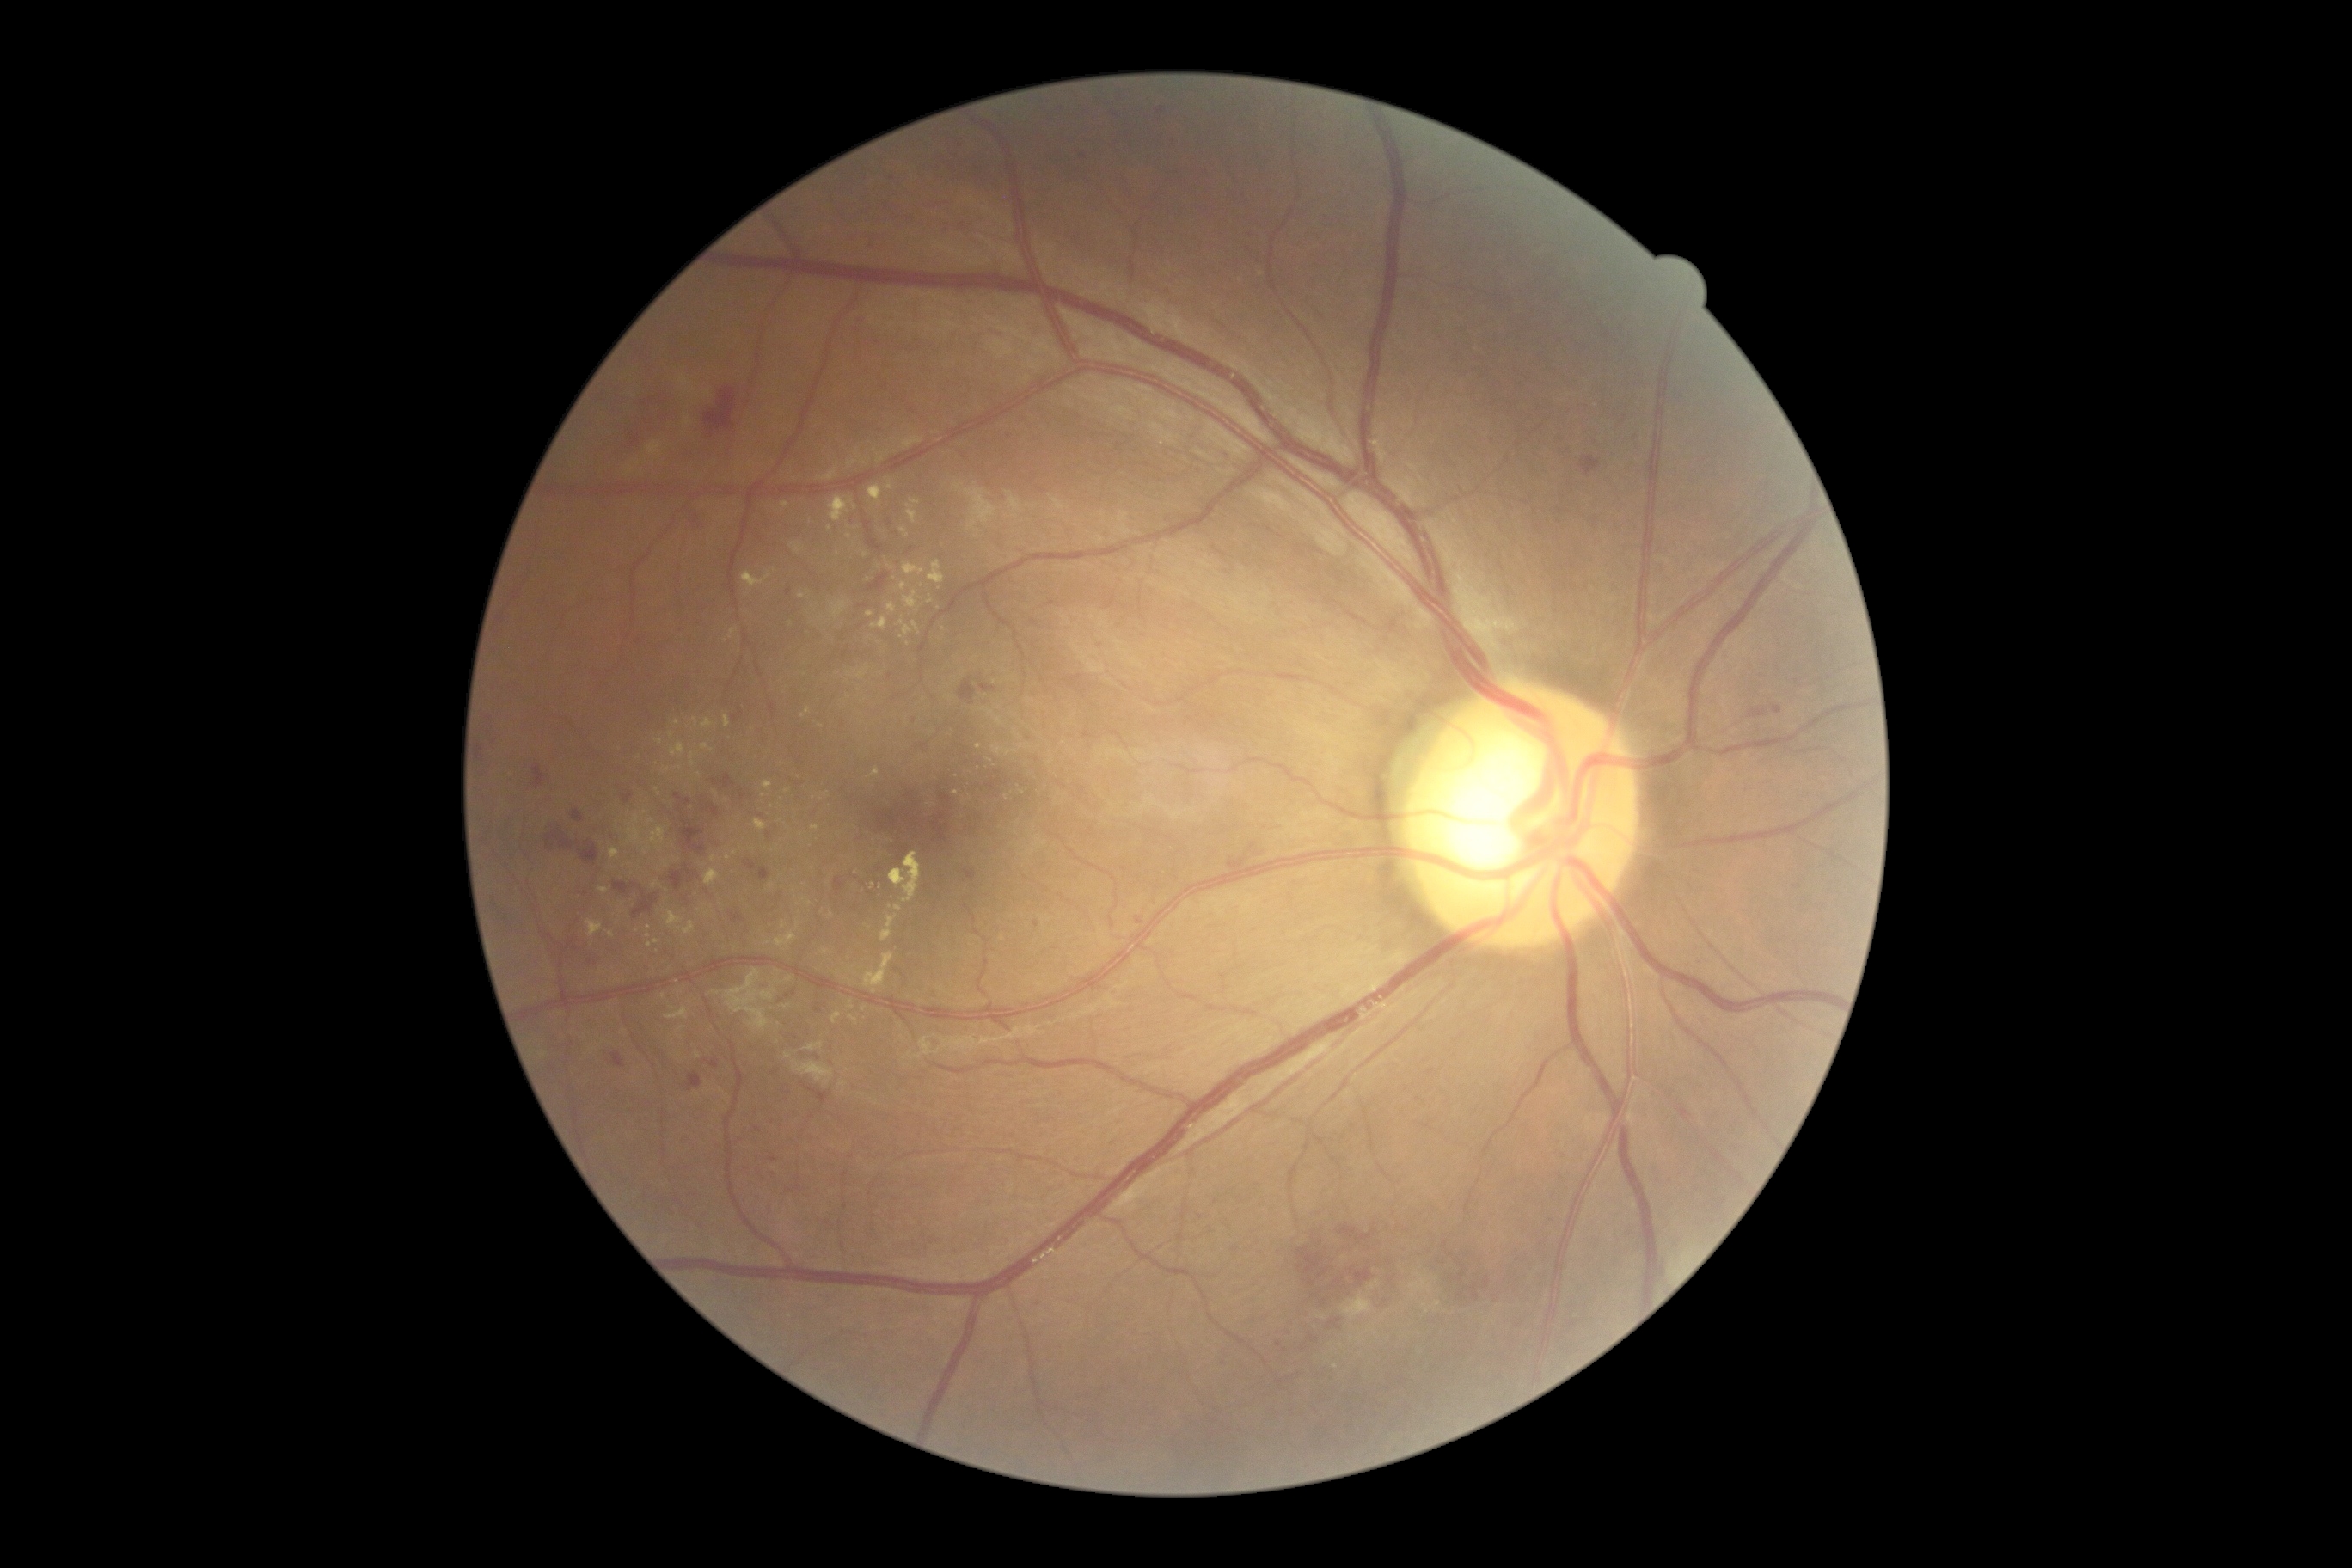

<lesions partial="true">
  <dr_grade>2</dr_grade>
  <ex partial="true"><region>909, 510, 917, 525</region> | <region>728, 628, 737, 640</region> | <region>682, 922, 695, 936</region> | <region>838, 1082, 847, 1089</region> | <region>831, 601, 848, 620</region> | <region>599, 888, 608, 893</region> | <region>830, 496, 854, 524</region> | <region>802, 709, 811, 718</region> | <region>704, 871, 721, 886</region></ex>
  <ex_small_centers>point(773, 807) | point(979, 747) | point(802, 596) | point(625, 1032) | point(910, 1056) | point(672, 735) | point(667, 864) | point(785, 1008)</ex_small_centers>
</lesions>